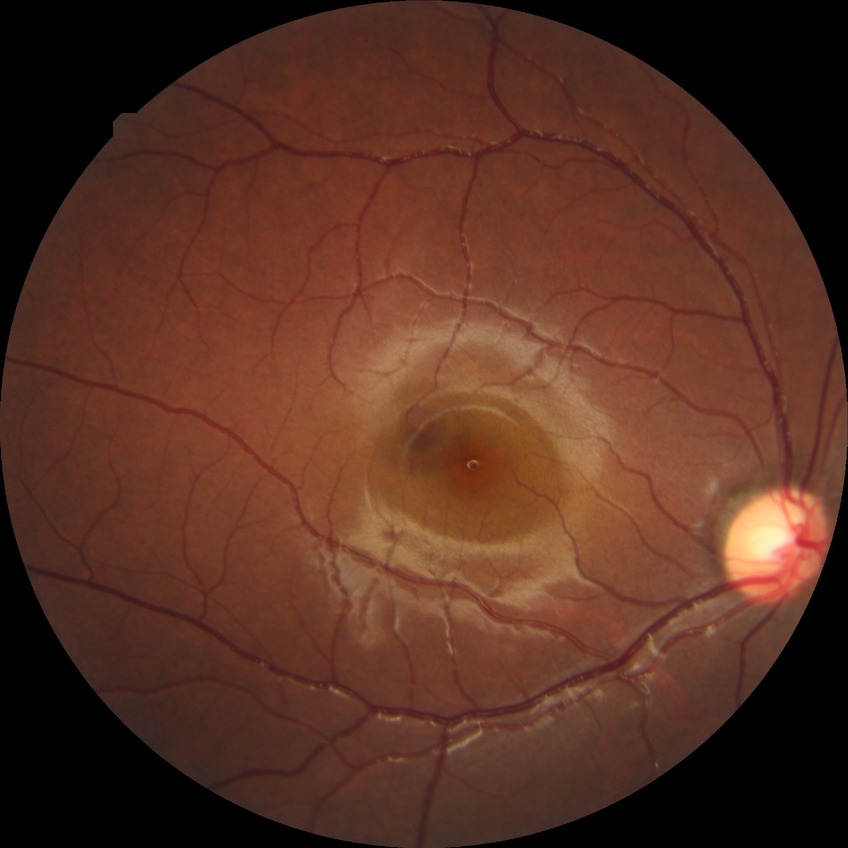 Davis grading: no diabetic retinopathy.